Color fundus photograph. FOV: 45 degrees
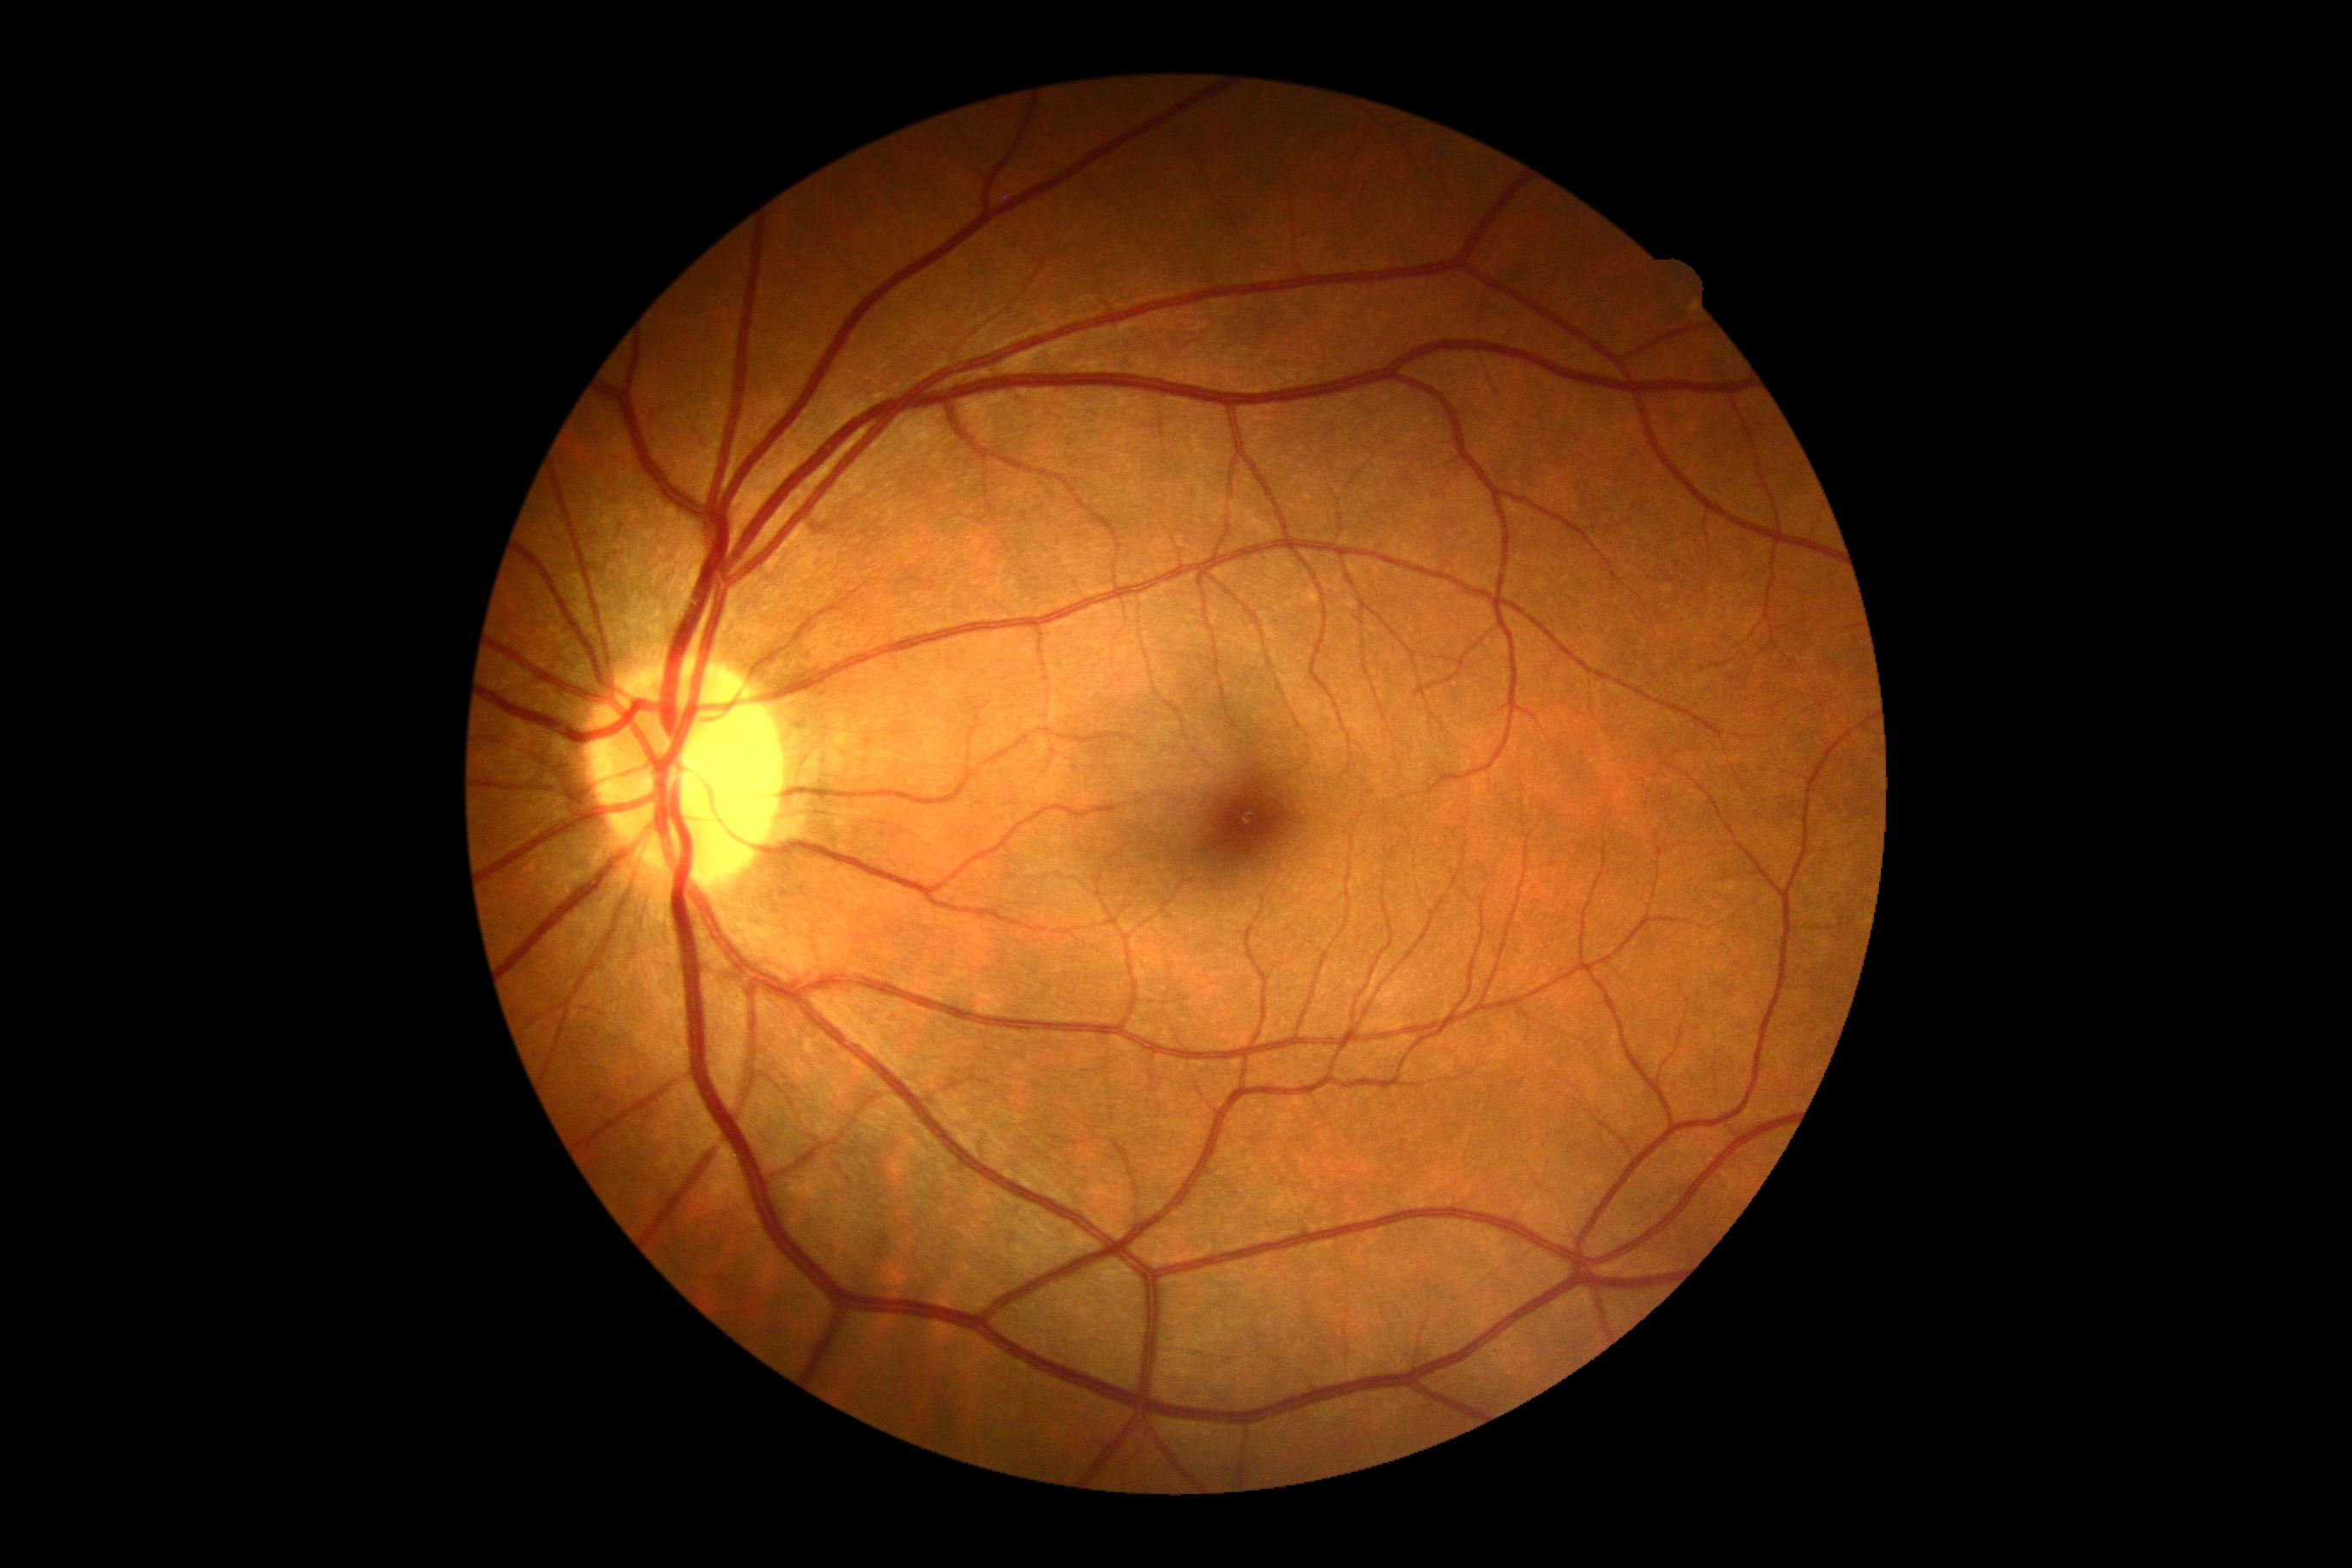
DR grade: 0/4.